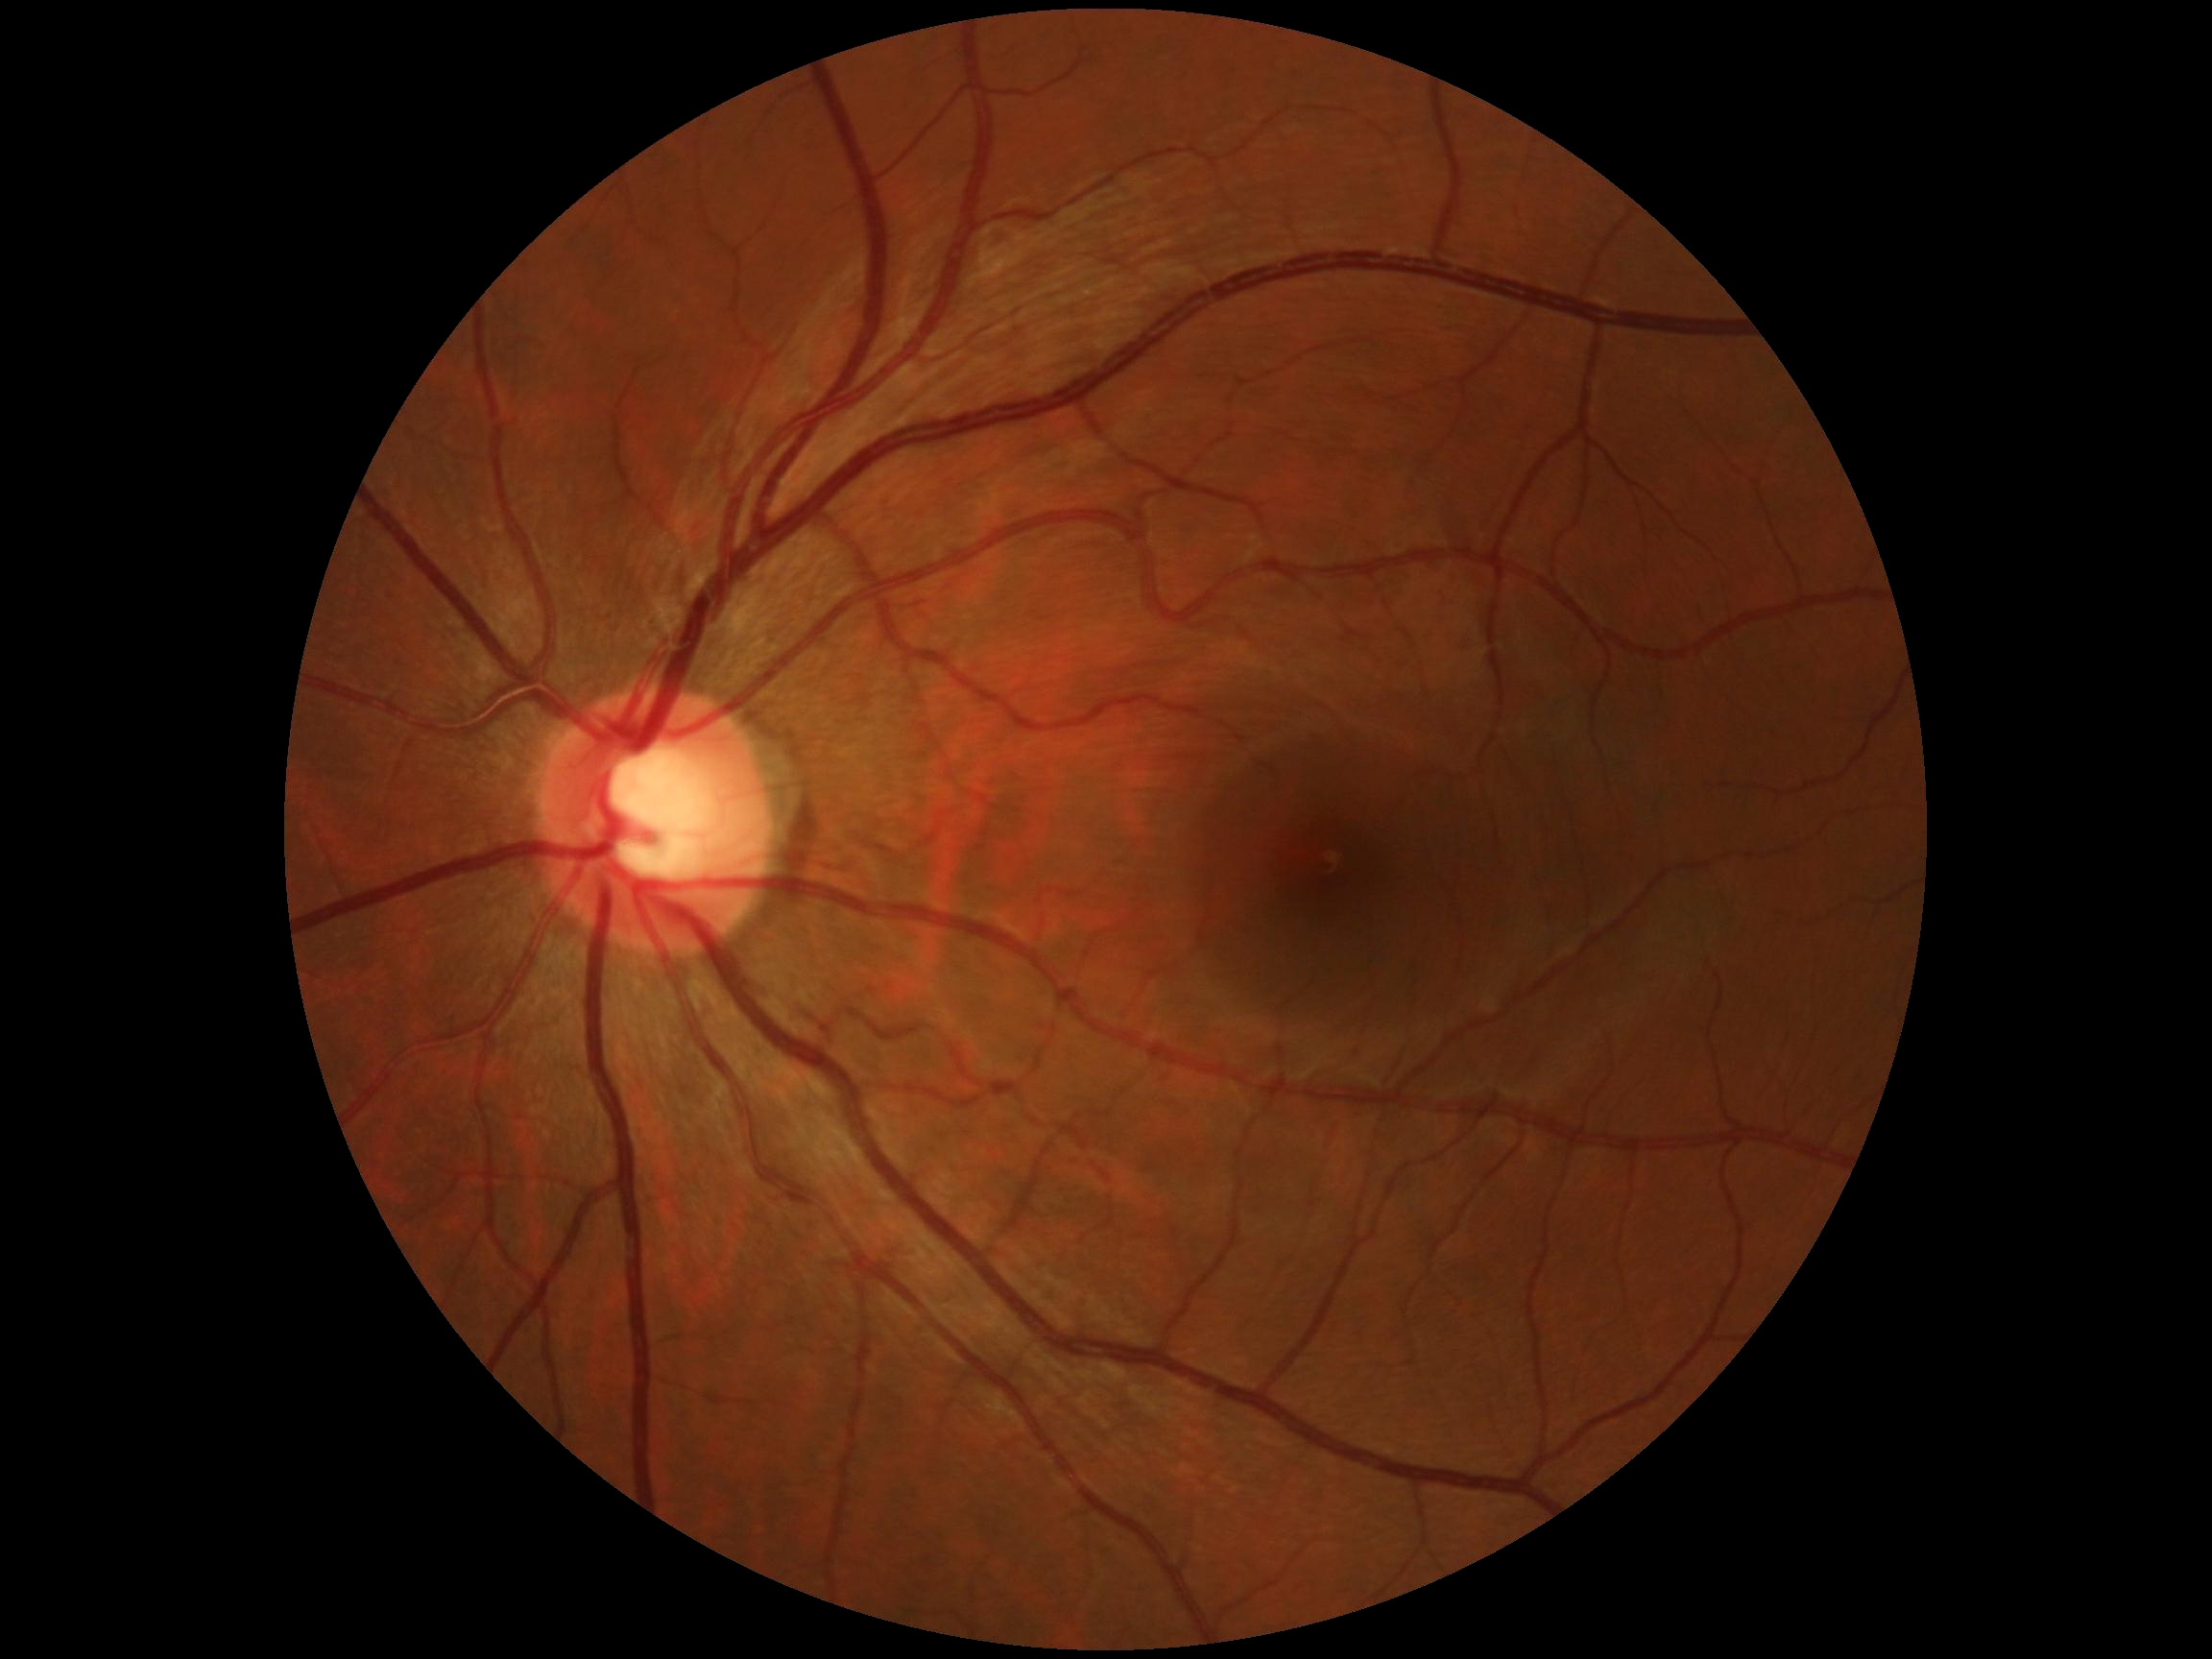

– DR grade: 0/4
– DR impression: no apparent DR